RetCam wide-field infant fundus image — 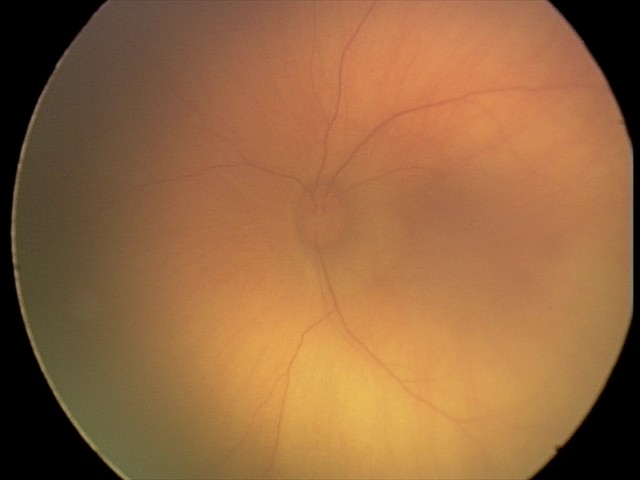
Screening examination consistent with retinal hemorrhages.